640x480. Wide-field fundus photograph of an infant
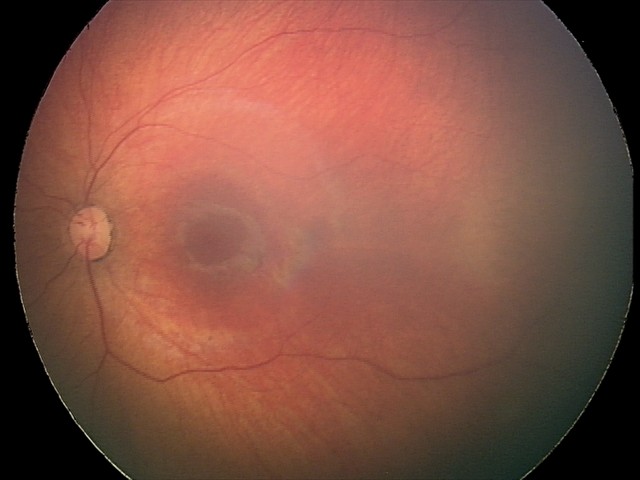 Diagnosis: retinal hemorrhages.